45 degree fundus photograph · nonmydriatic fundus photograph · color fundus image · NIDEK AFC-230
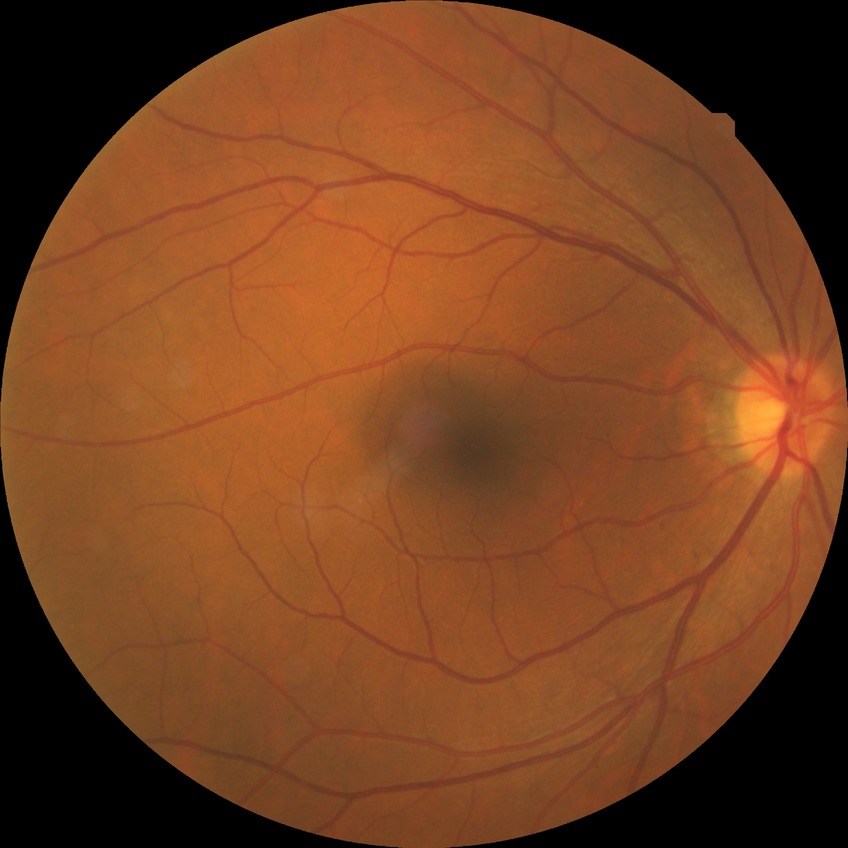 {"davis_grade": "NDR (no diabetic retinopathy)"}